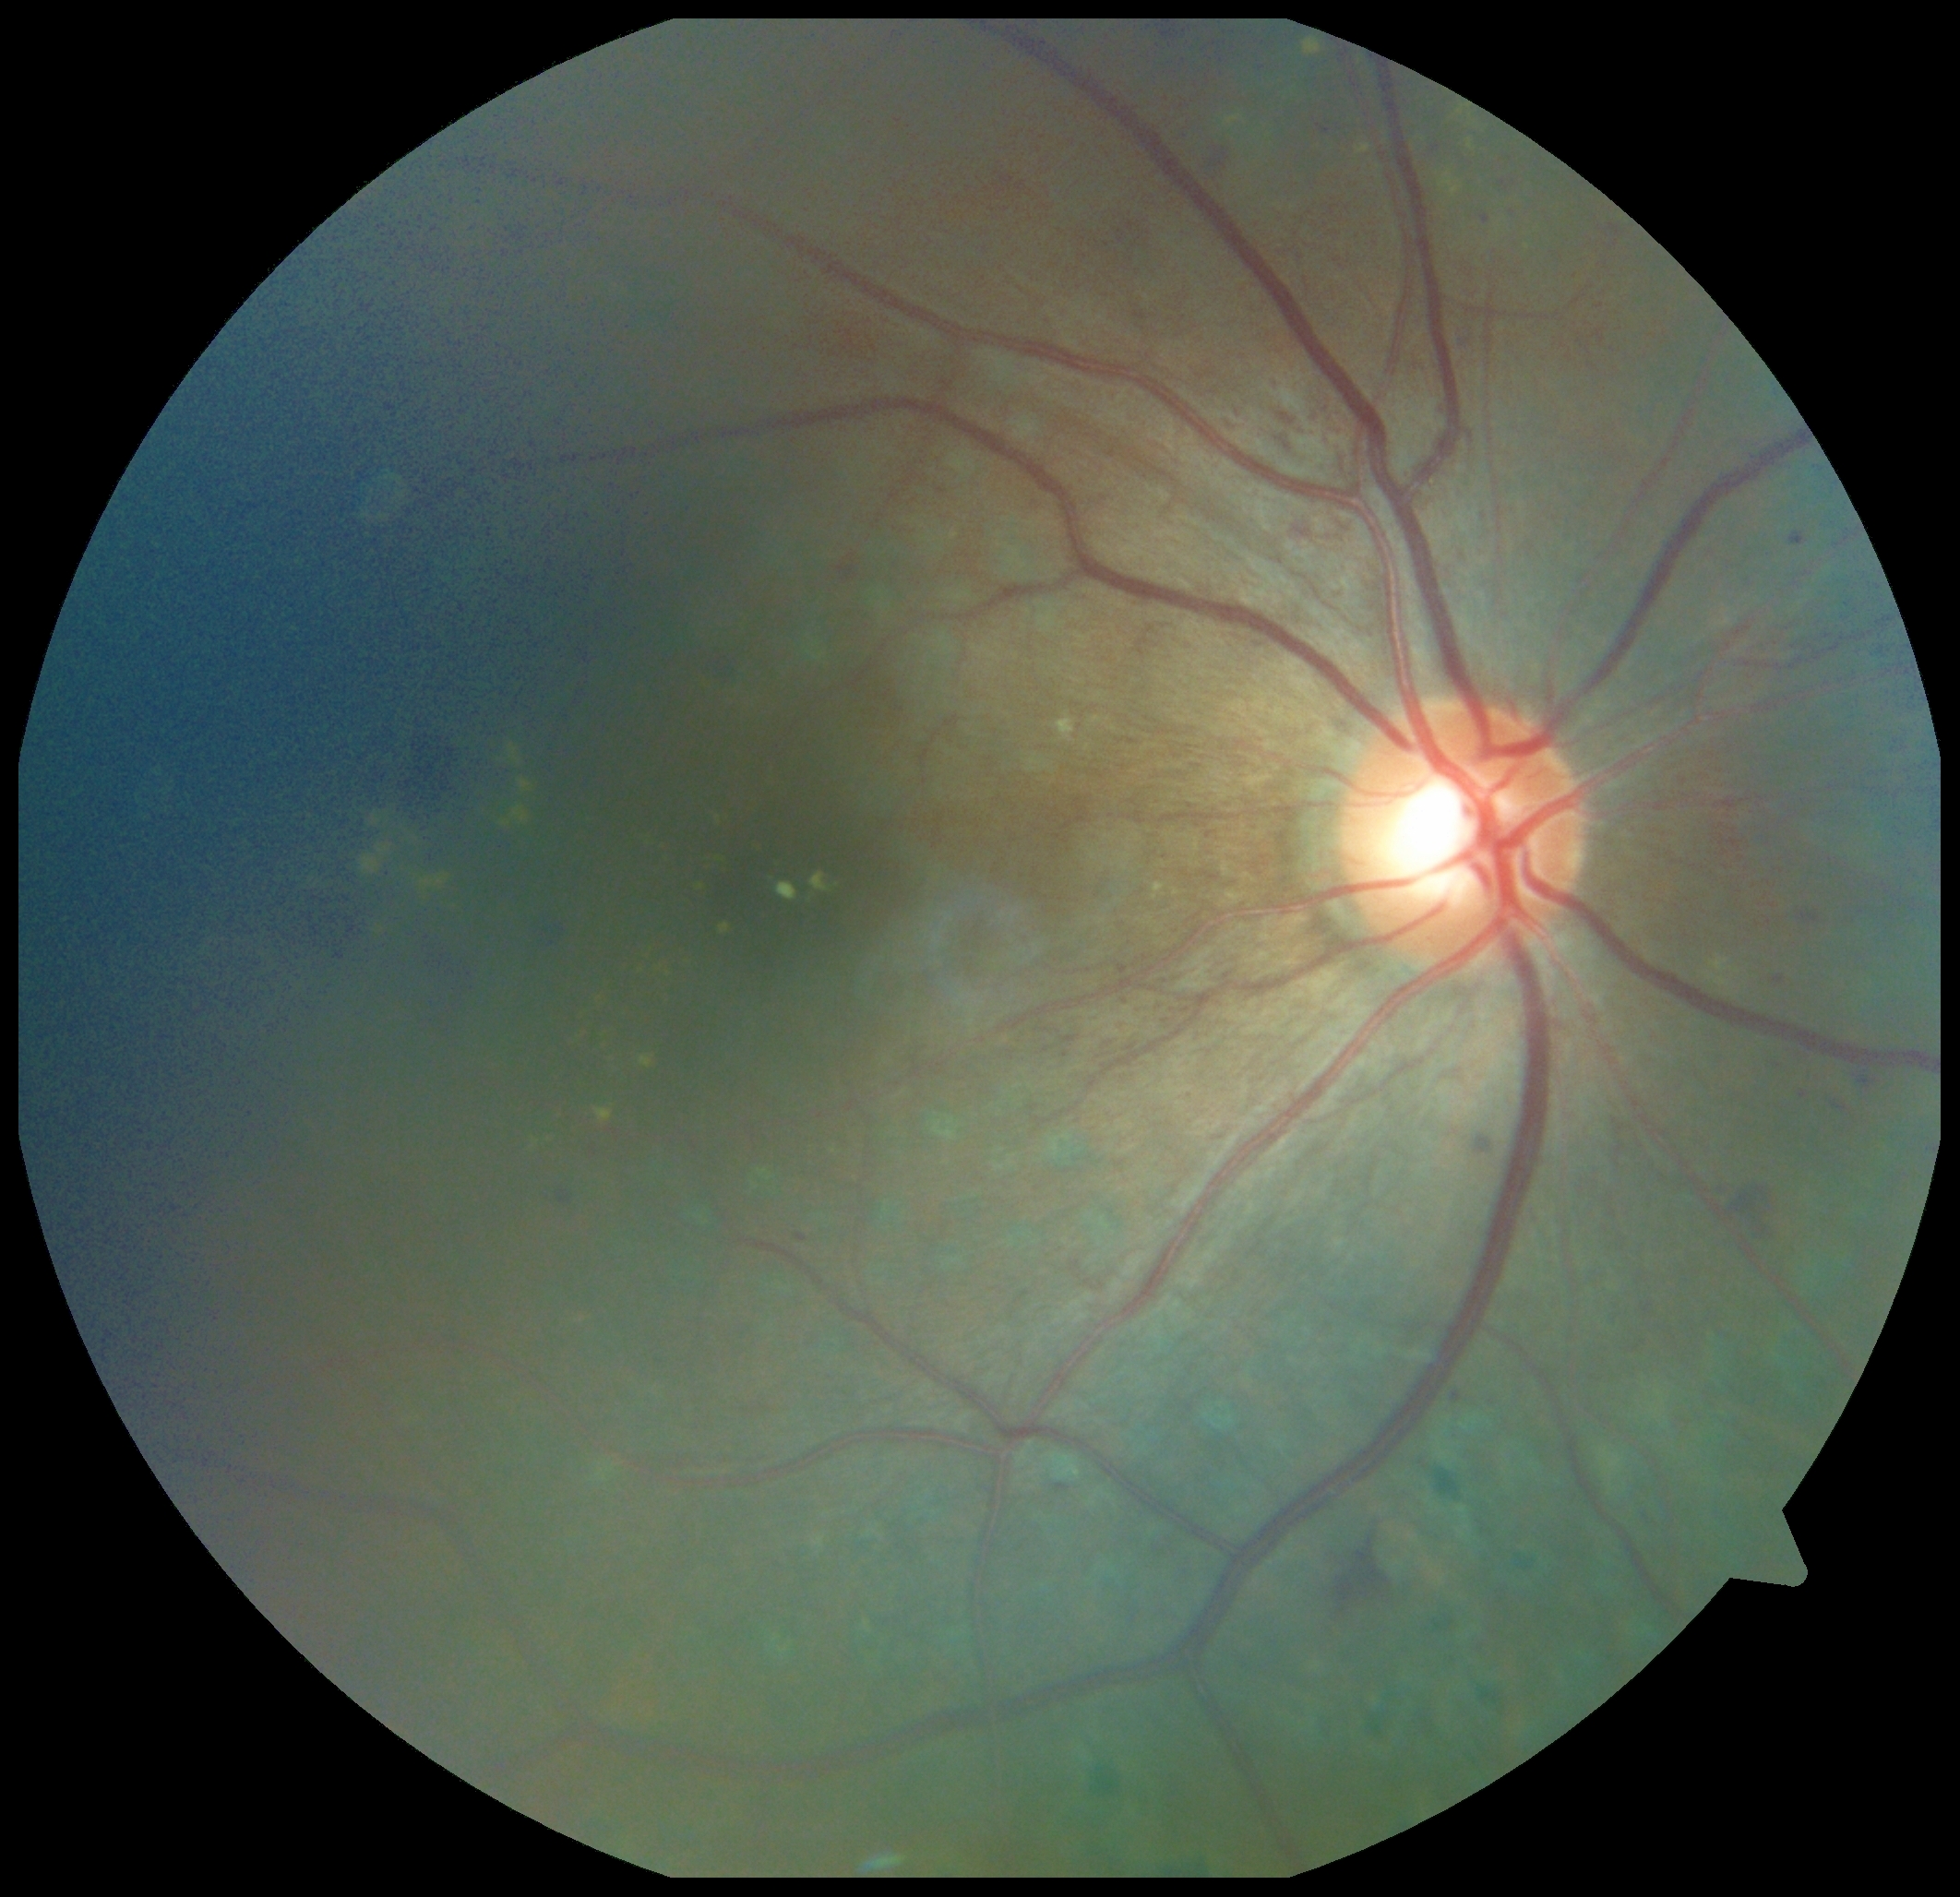
Diabetic retinopathy (DR): grade 2.